FOV: 45 degrees · color fundus photograph · 2352 x 1568 pixels — 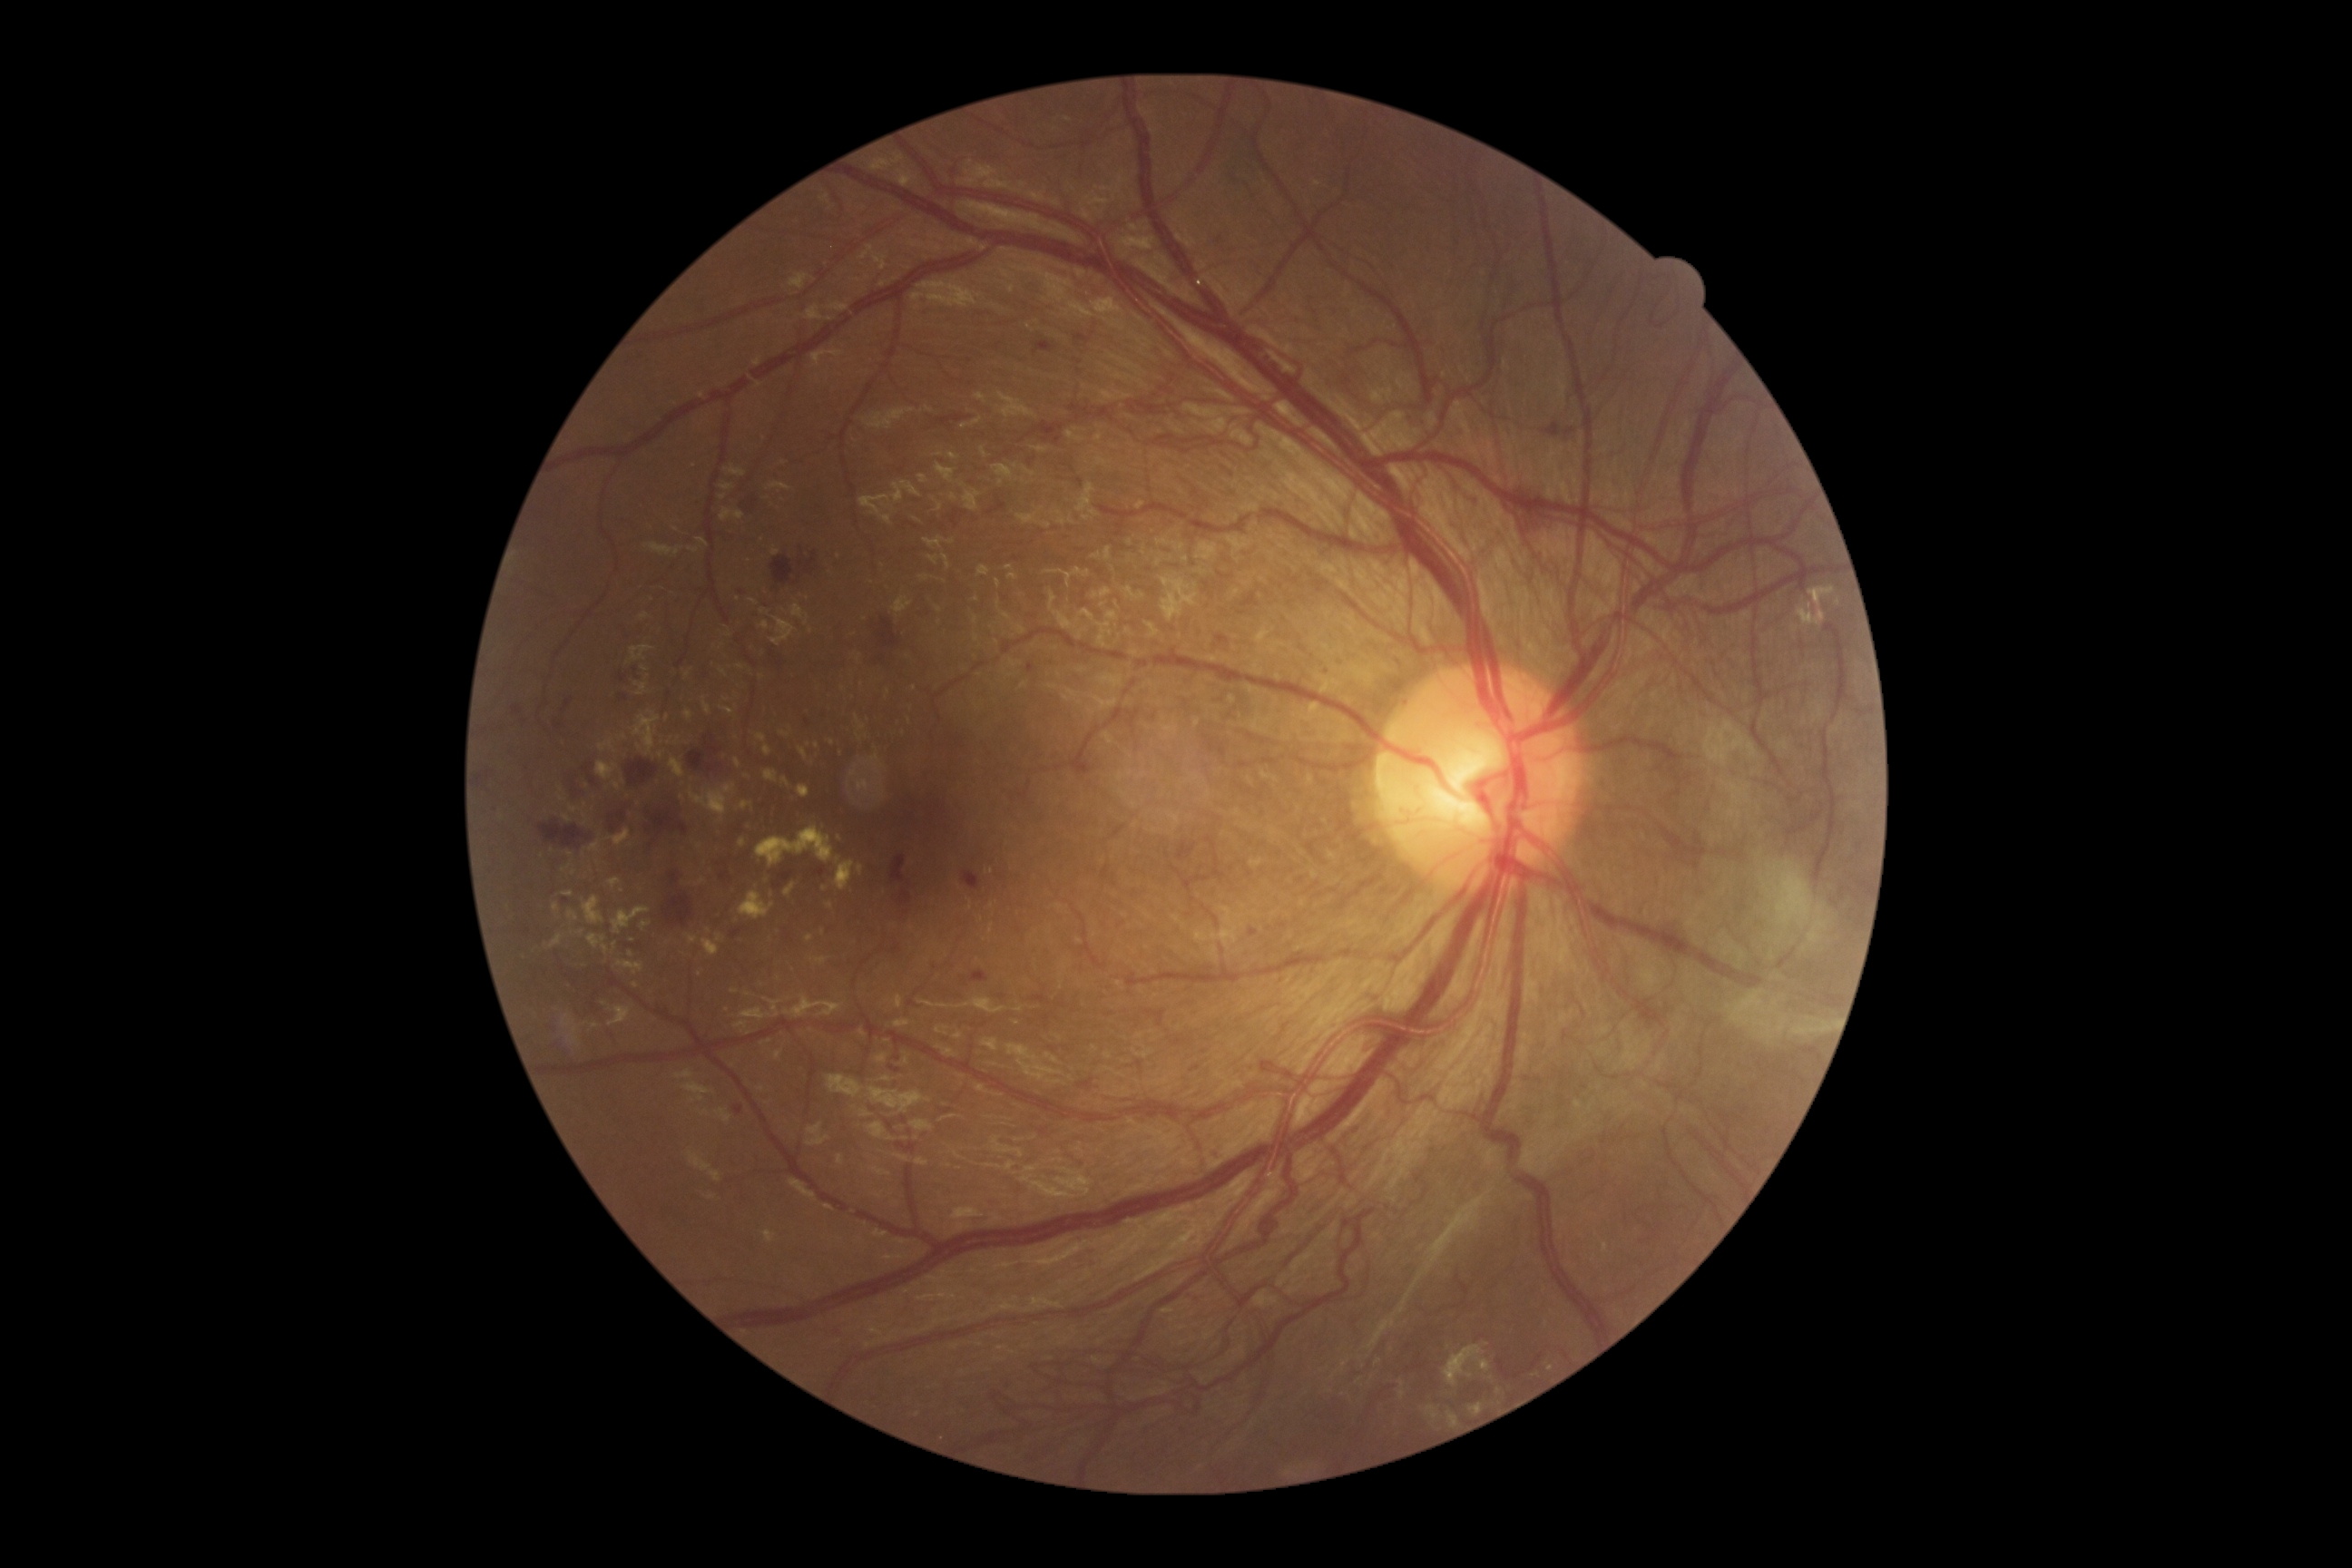

DR grade is 4 (PDR).
HEs are present, including at <region>774, 930, 799, 954</region> | <region>890, 856, 906, 885</region> | <region>618, 674, 627, 681</region> | <region>1175, 1135, 1191, 1159</region> | <region>1144, 1135, 1157, 1146</region> | <region>988, 502, 1008, 514</region> | <region>1210, 1152, 1224, 1164</region> | <region>1073, 333, 1092, 346</region> | <region>721, 921, 767, 941</region> | <region>1217, 636, 1230, 645</region> | <region>549, 1039, 582, 1064</region> | <region>1026, 663, 1035, 674</region> | <region>1297, 647, 1308, 662</region>.
Smaller HEs around (635,670) | (777,886) | (882,660) | (1316,313).
EXs are present, including at <region>1574, 1101, 1583, 1110</region> | <region>685, 934, 698, 945</region> | <region>798, 785, 810, 799</region> | <region>589, 841, 600, 852</region> | <region>779, 732, 790, 738</region> | <region>781, 778, 790, 789</region> | <region>1798, 587, 1836, 627</region> | <region>564, 814, 571, 823</region> | <region>701, 939, 720, 957</region> | <region>596, 761, 618, 781</region>.
Smaller EXs around (631,954) | (735,992) | (645,669) | (861,739) | (580,934) | (640,805) | (585,805) | (914,689).